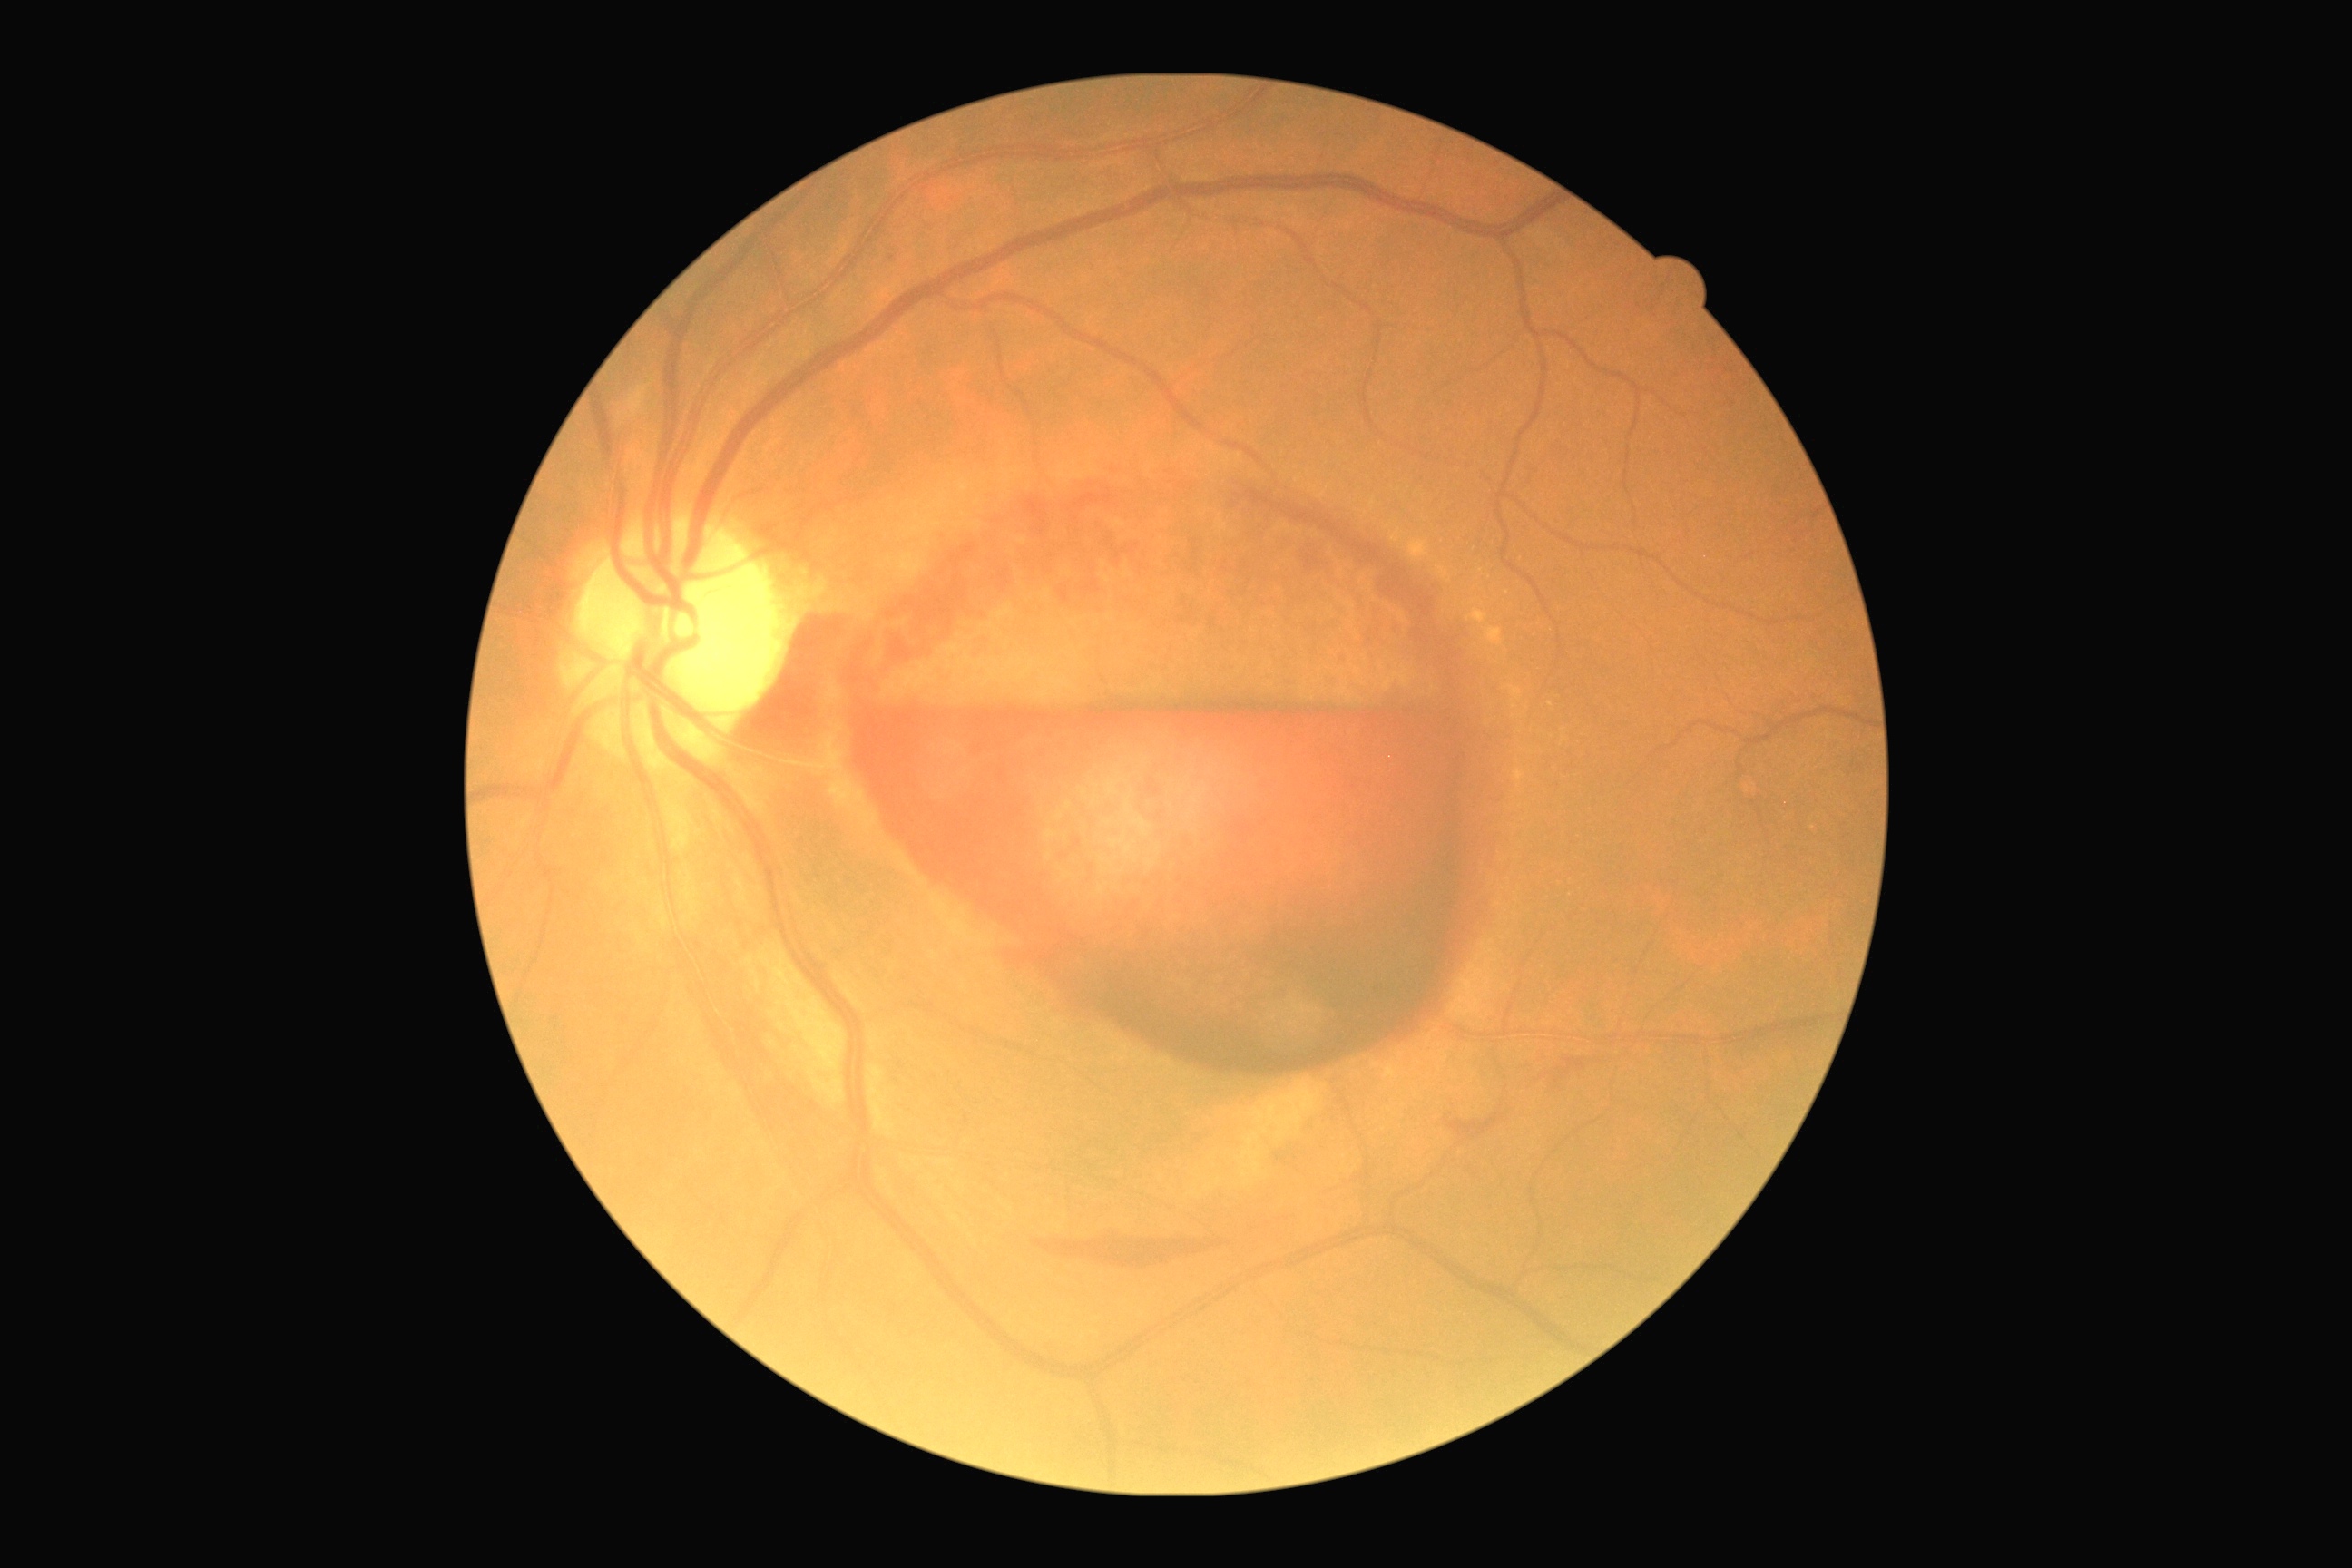
Annotations:
- DR severity: PDR (grade 4)
- DR class: proliferative diabetic retinopathy